Retinal fundus photograph. 1932x1910px. 45° FOV.
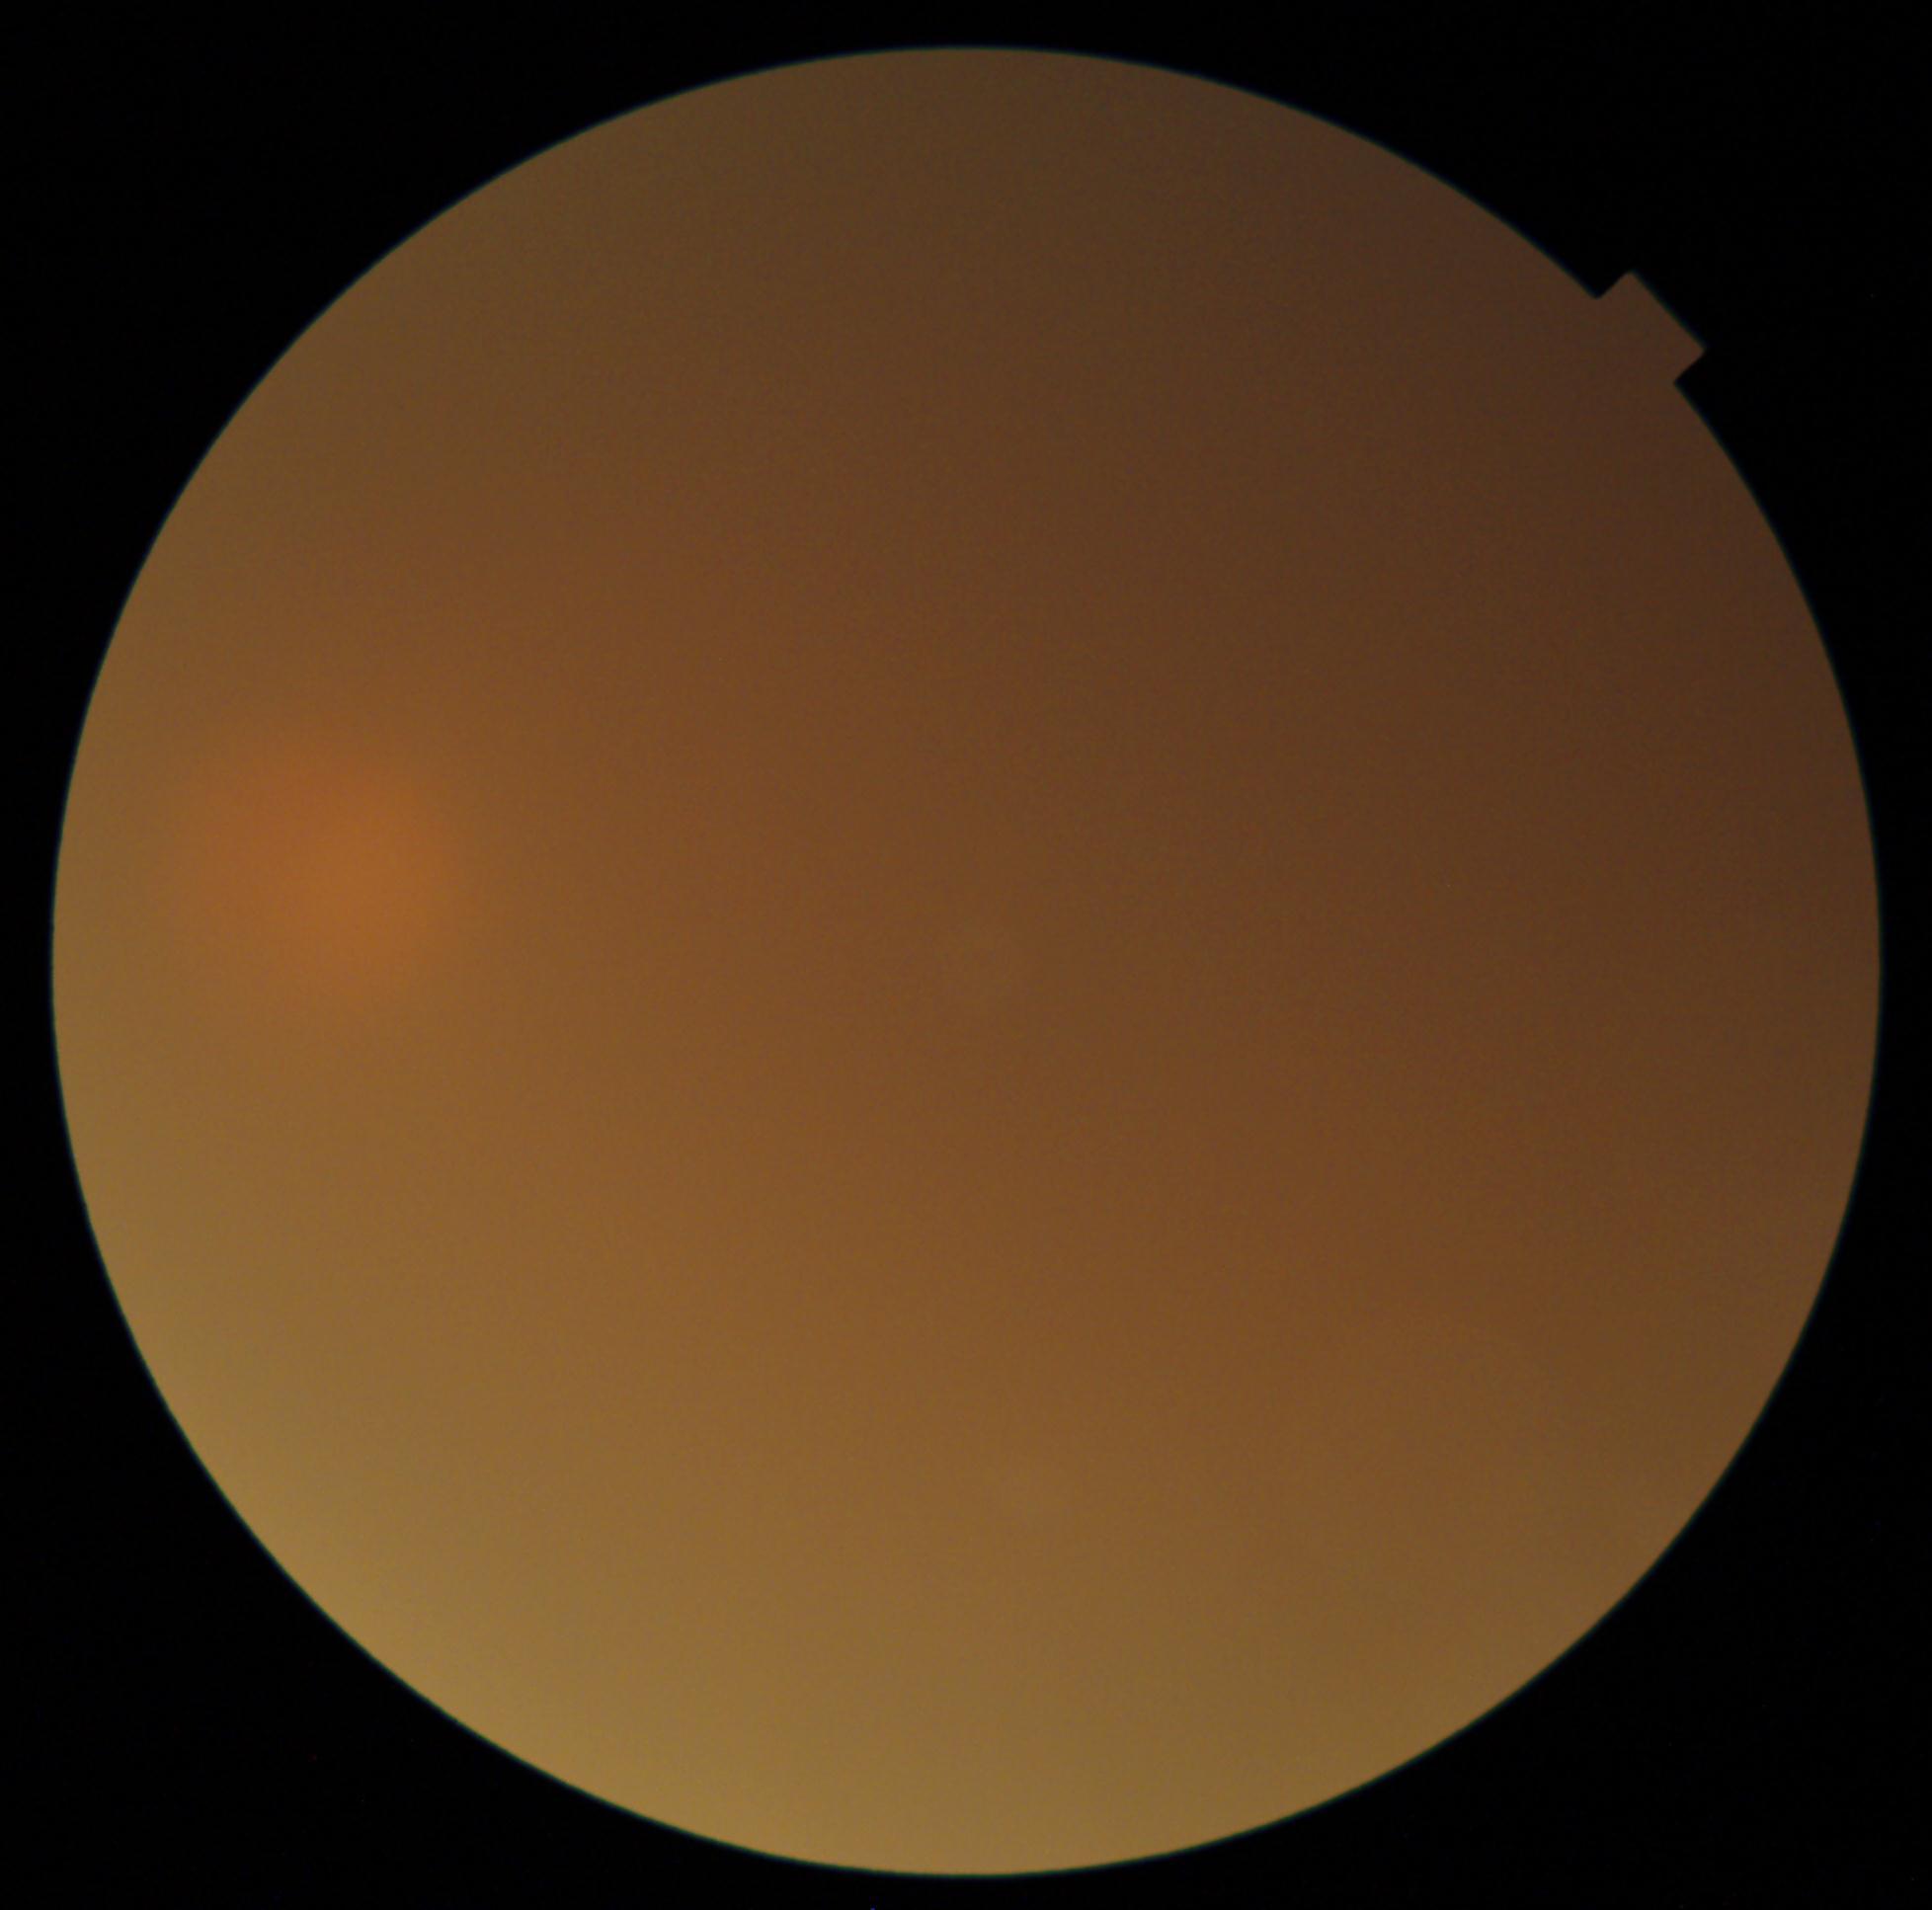 DR grade is ungradable due to poor image quality.